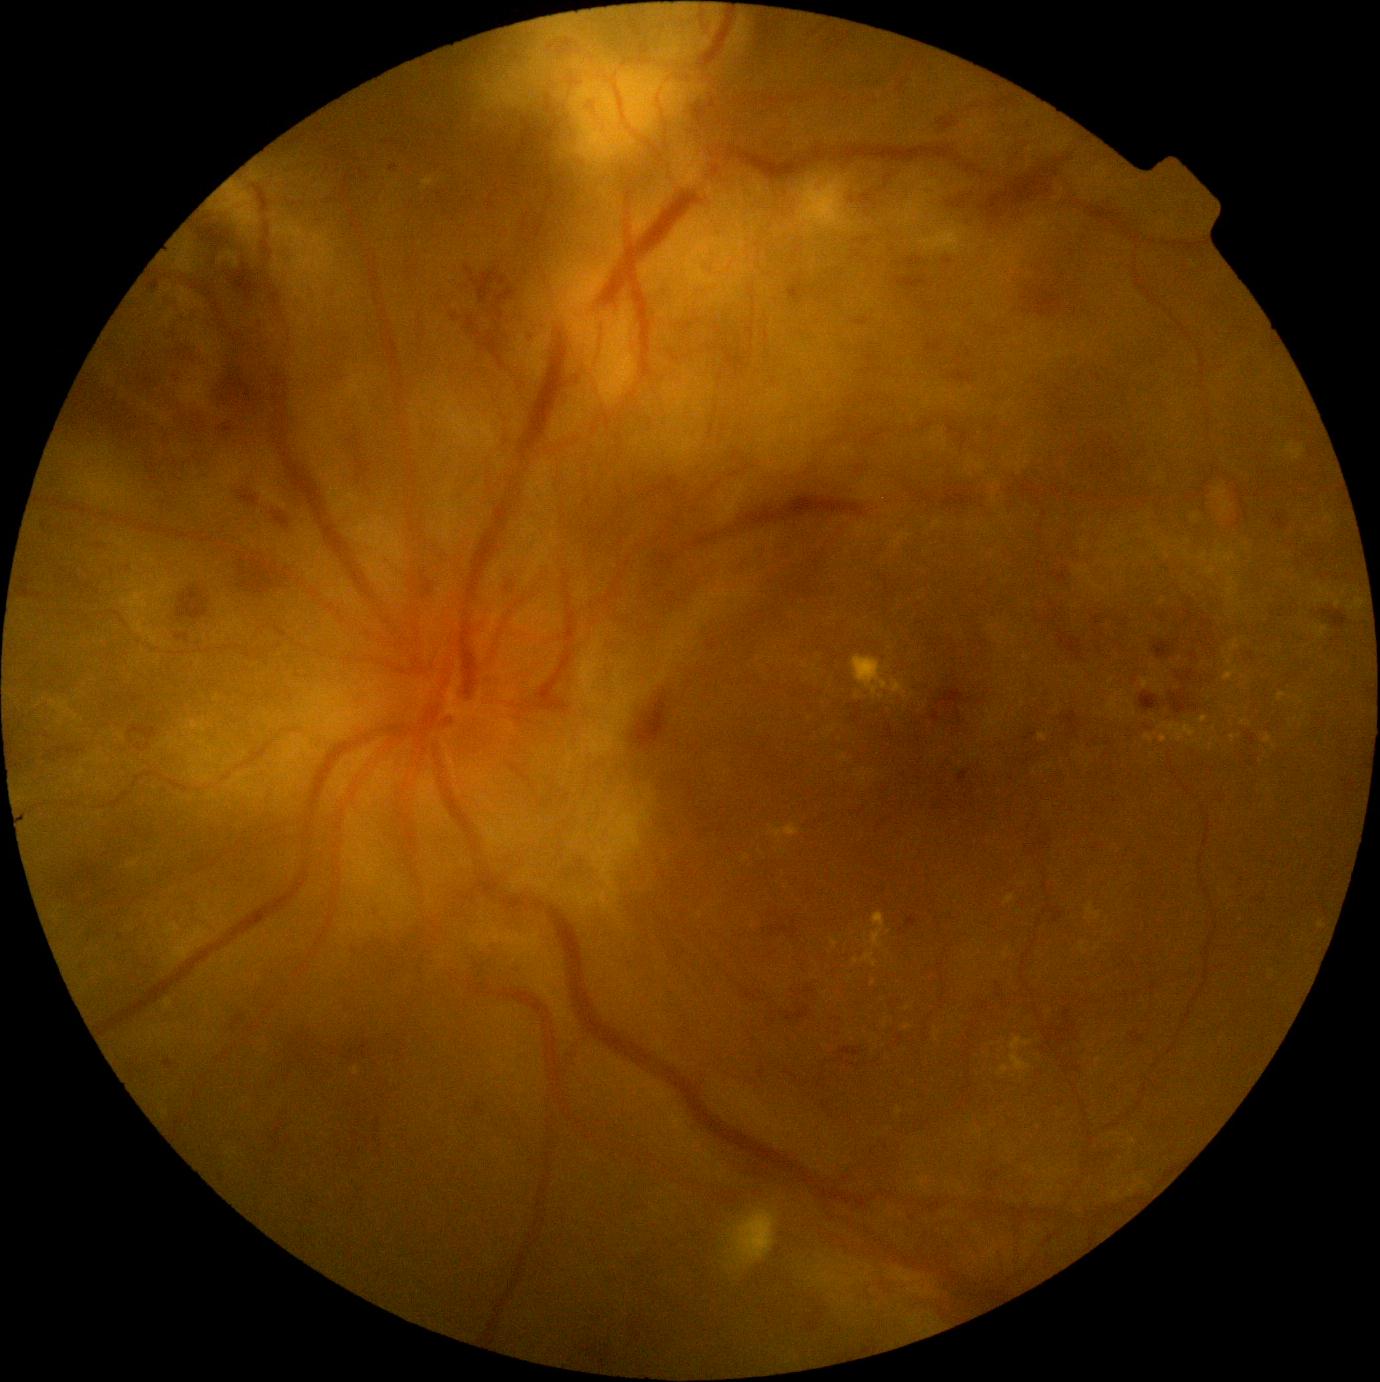

Diabetic retinopathy (DR): 4.